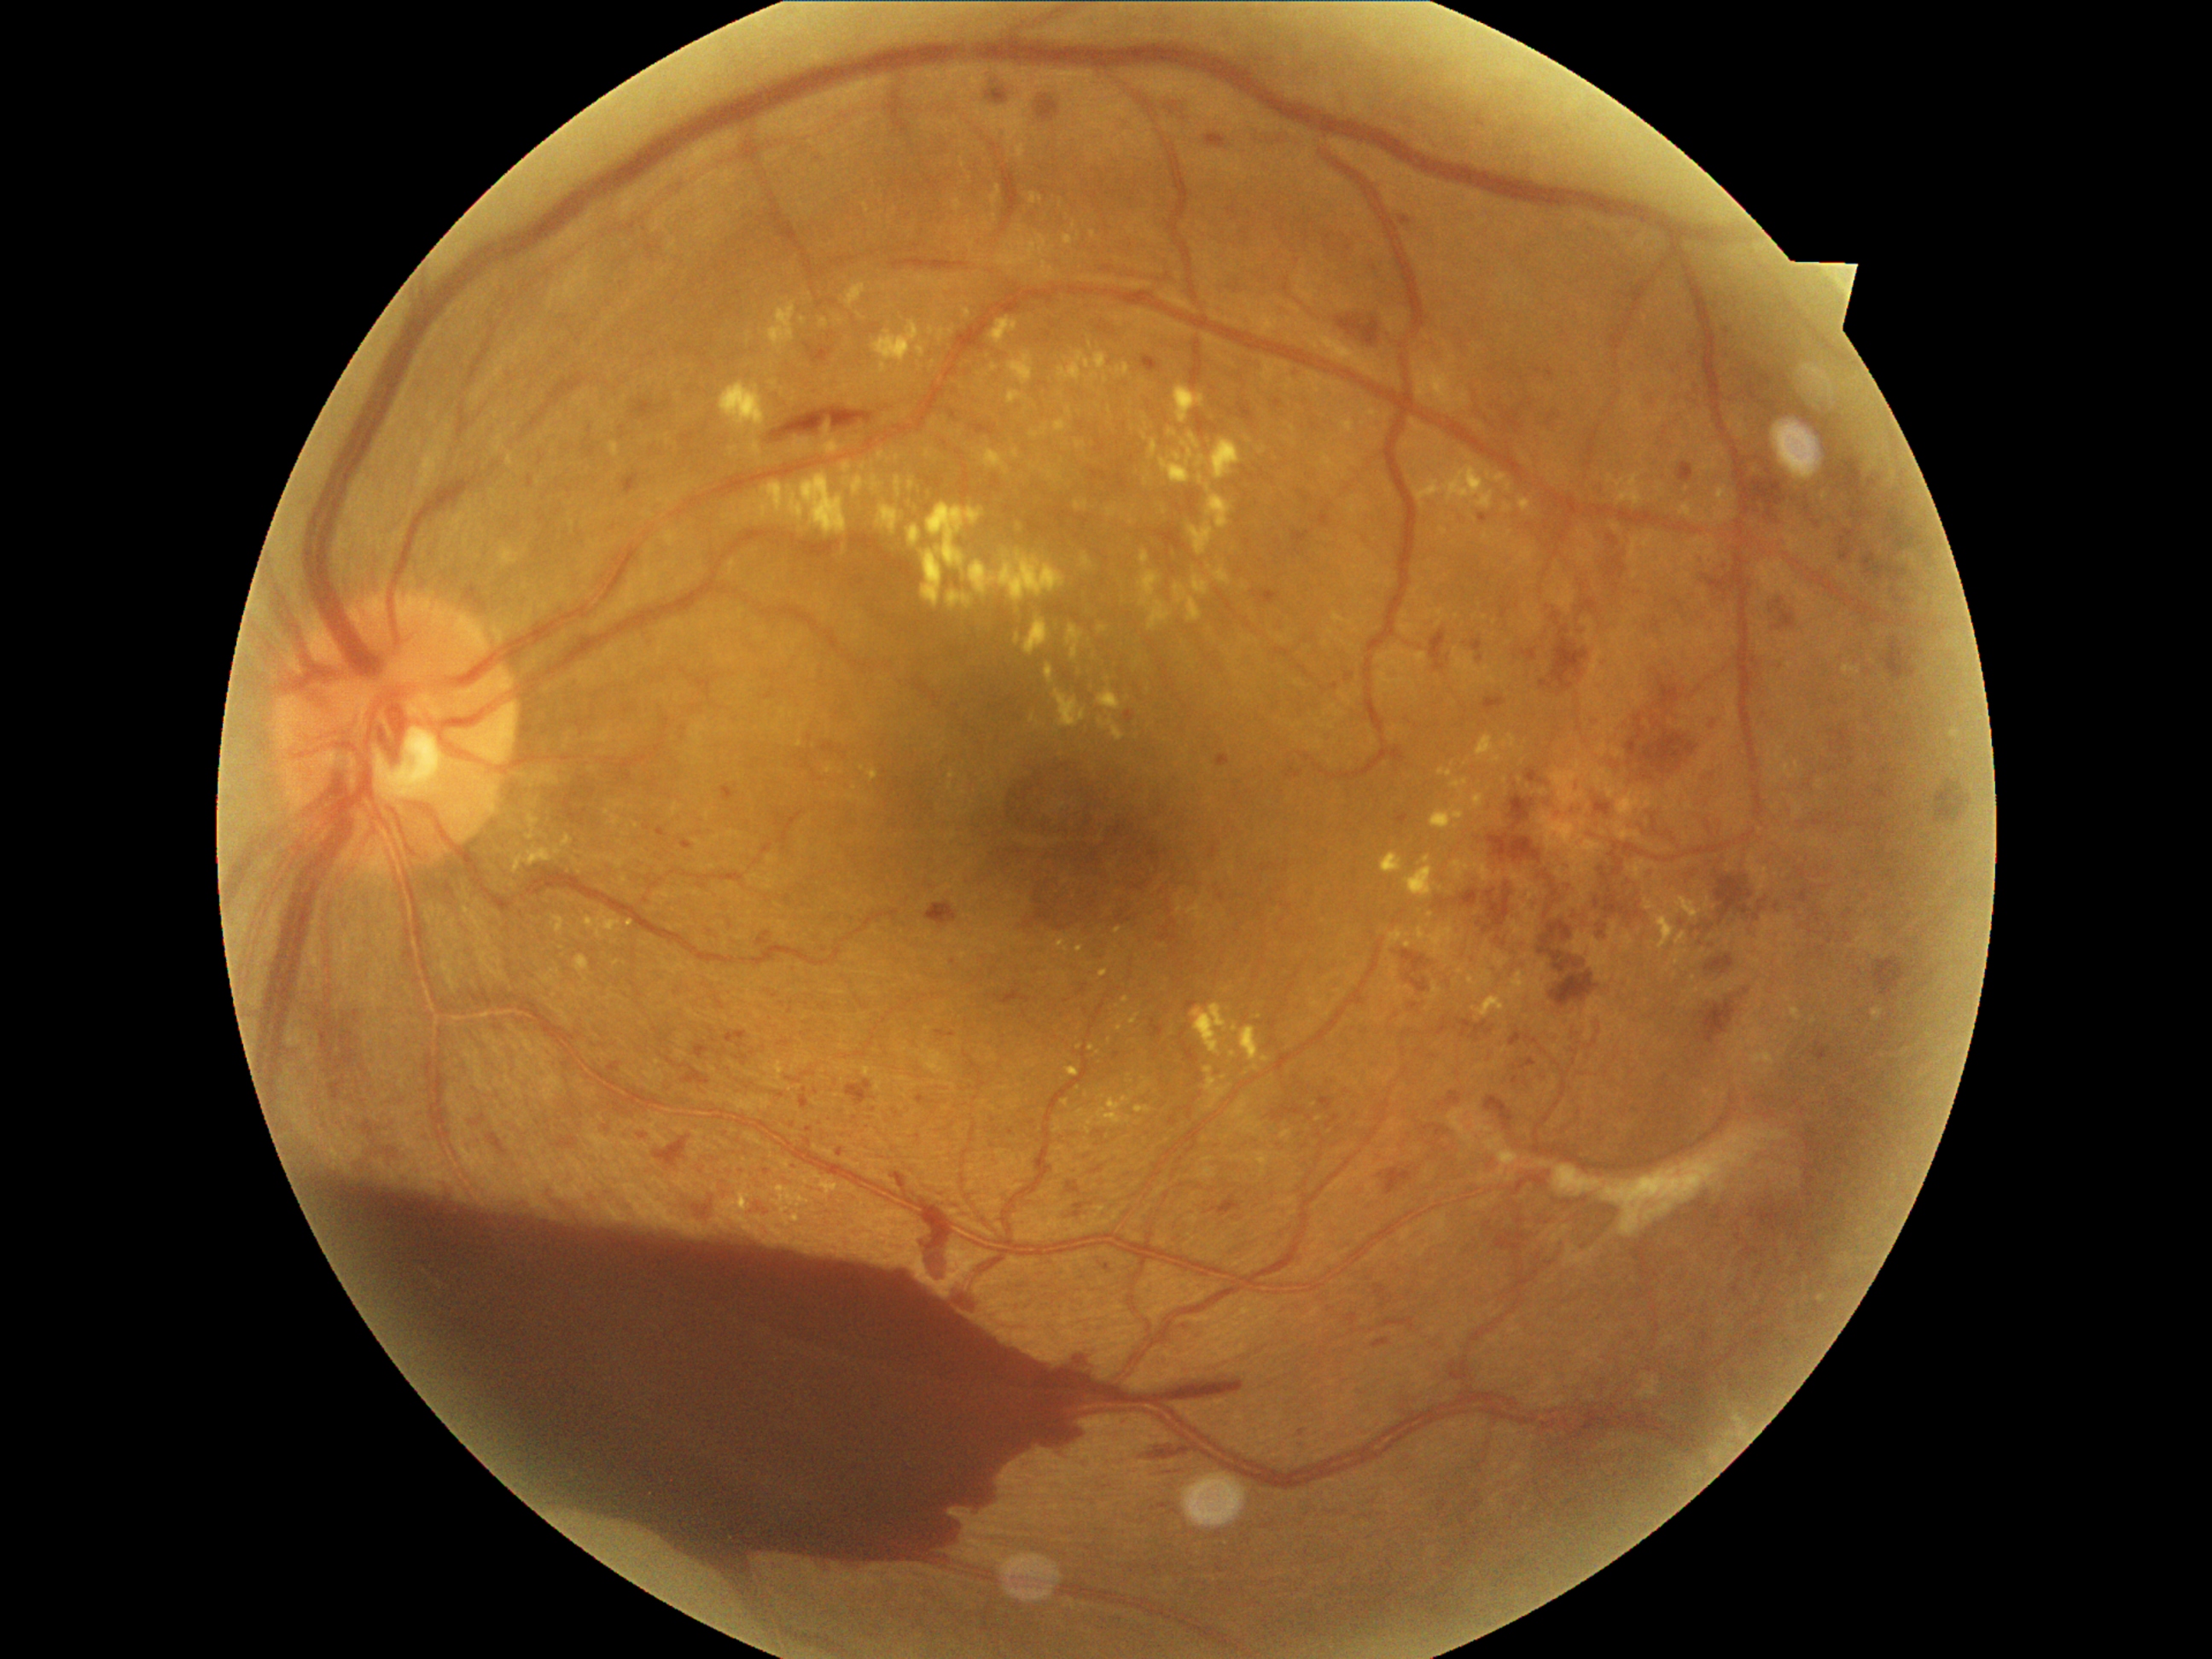 {"partial": true, "dr_grade": 4, "dr_grade_name": "PDR", "lesions": {"ex": [[796, 740, 803, 748], [765, 301, 796, 352], [1057, 938, 1069, 955], [1054, 421, 1068, 433], [1416, 356, 1470, 412], [1390, 965, 1399, 981], [1187, 521, 1214, 556], [970, 242, 975, 250], [820, 320, 829, 329], [1066, 626, 1085, 661], [1429, 981, 1441, 1003], [924, 450, 934, 458], [965, 221, 972, 236], [948, 591, 974, 608]], "ex_small_approx": [[1021, 229], [1409, 988], [1146, 436], [1404, 1020], [1209, 567]], "ma": [[1293, 532, 1312, 554], [1518, 1559, 1525, 1568], [602, 1129, 612, 1136], [1091, 1167, 1103, 1173], [1211, 844, 1223, 859], [656, 827, 667, 837], [1552, 614, 1561, 626], [1895, 537, 1907, 550], [846, 1078, 875, 1105], [1206, 136, 1226, 151], [1887, 518, 1902, 533], [755, 933, 772, 948], [917, 1097, 933, 1105], [682, 1066, 711, 1085]], "ma_small_approx": [[1302, 1432], [954, 1035], [792, 1011], [1521, 378], [1219, 1074], [1442, 903]]}}